Retinal fundus photograph: 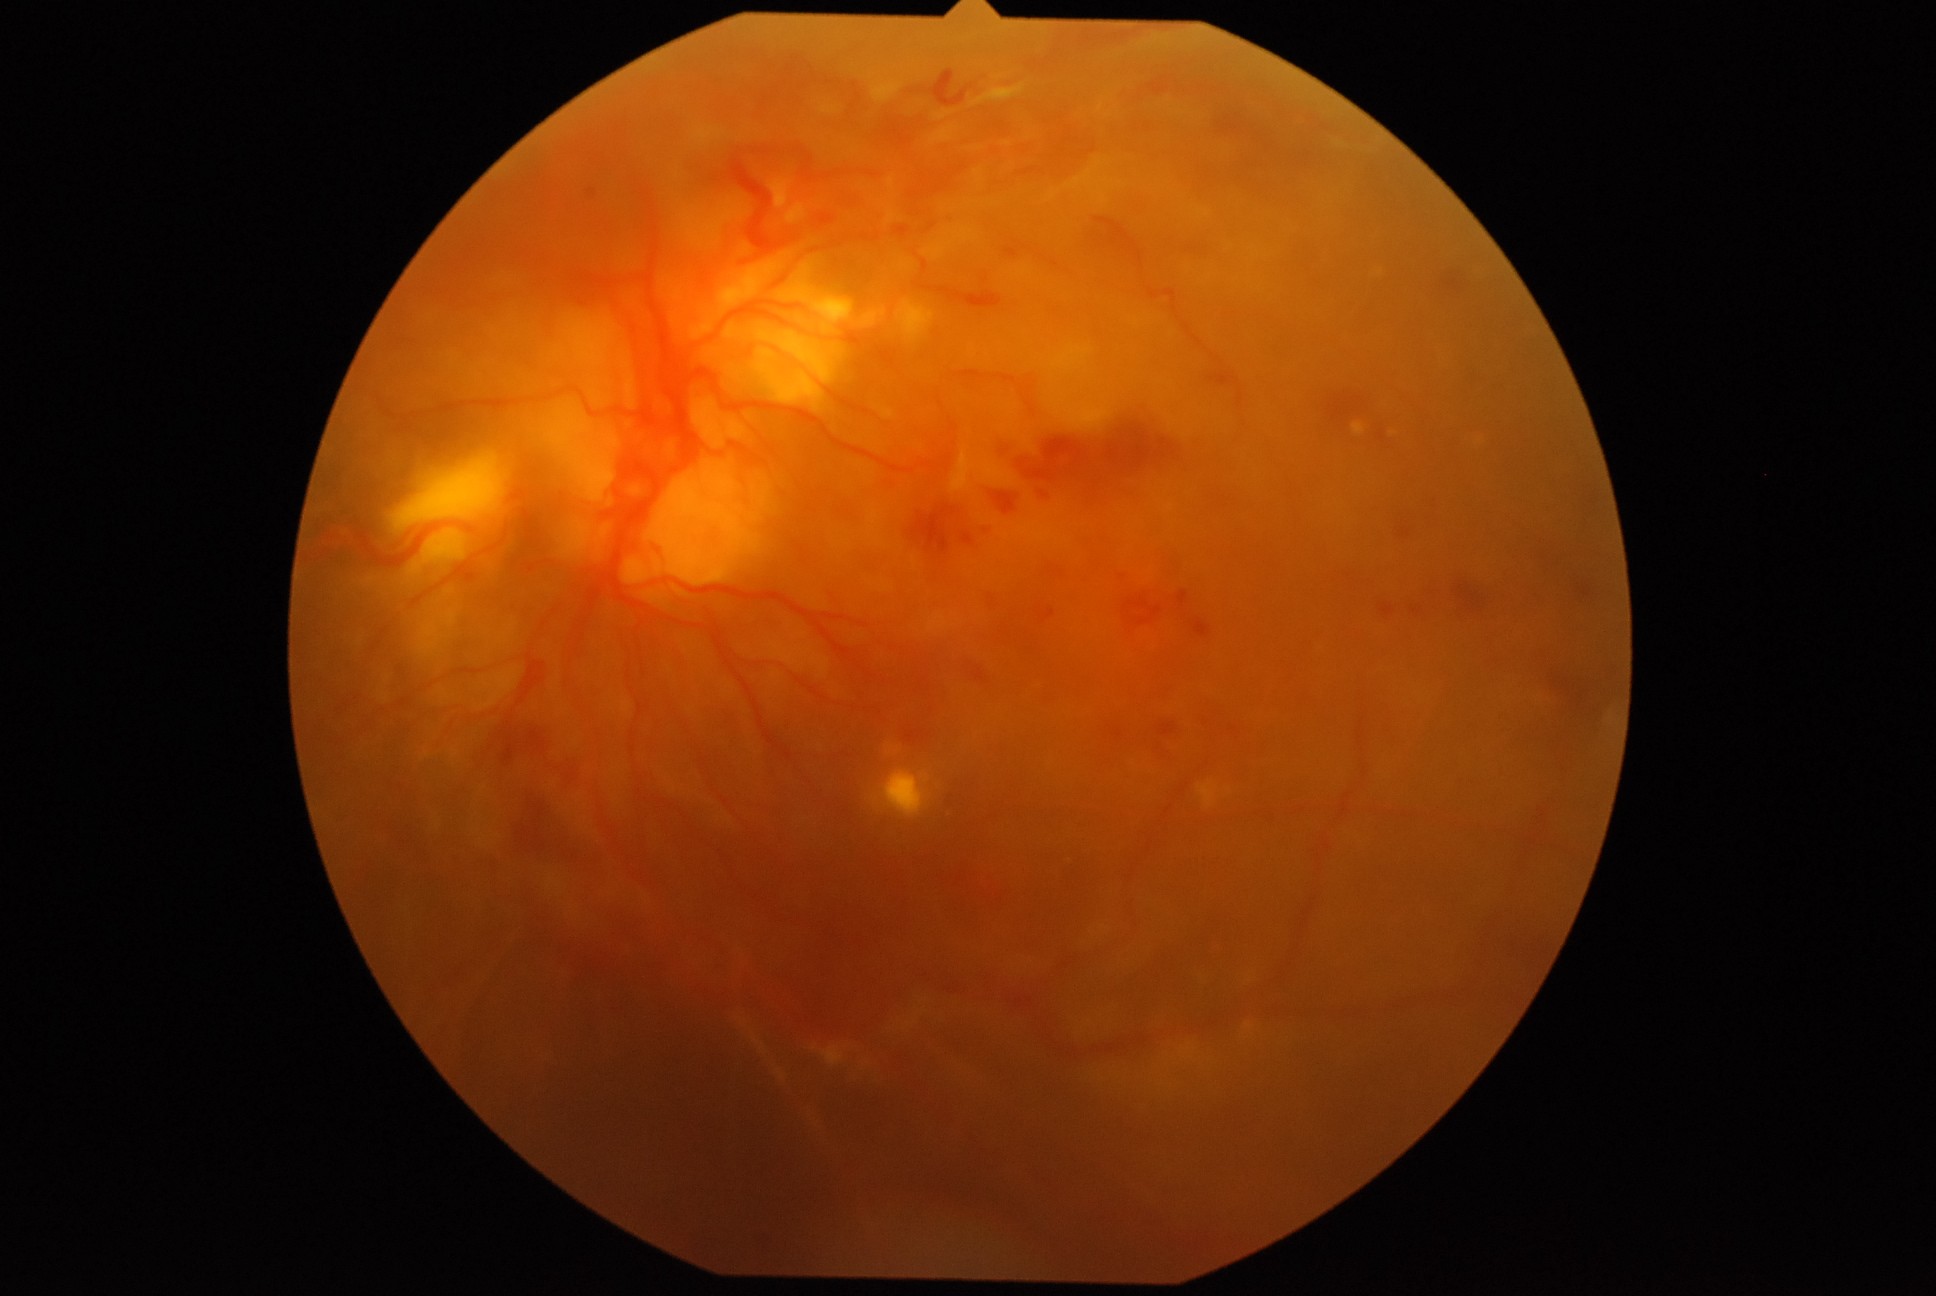

DR severity is PDR (grade 4). The retinopathy is classified as proliferative diabetic retinopathy.